NIDEK AFC-230, DR severity per modified Davis staging: 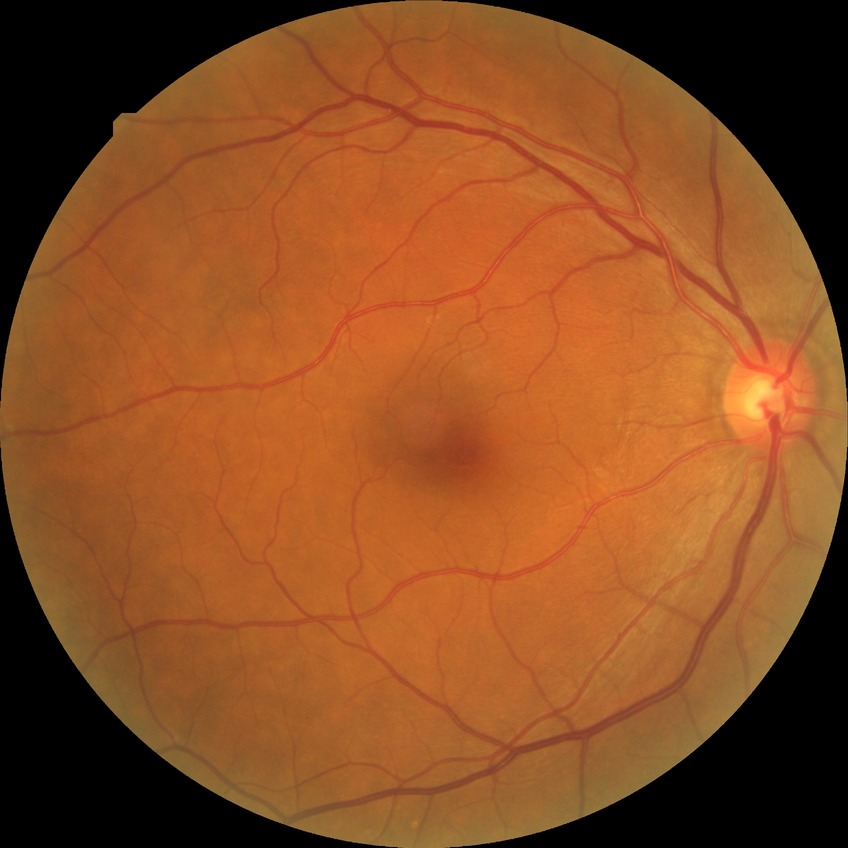 Davis stage: NDR. No signs of diabetic retinopathy.